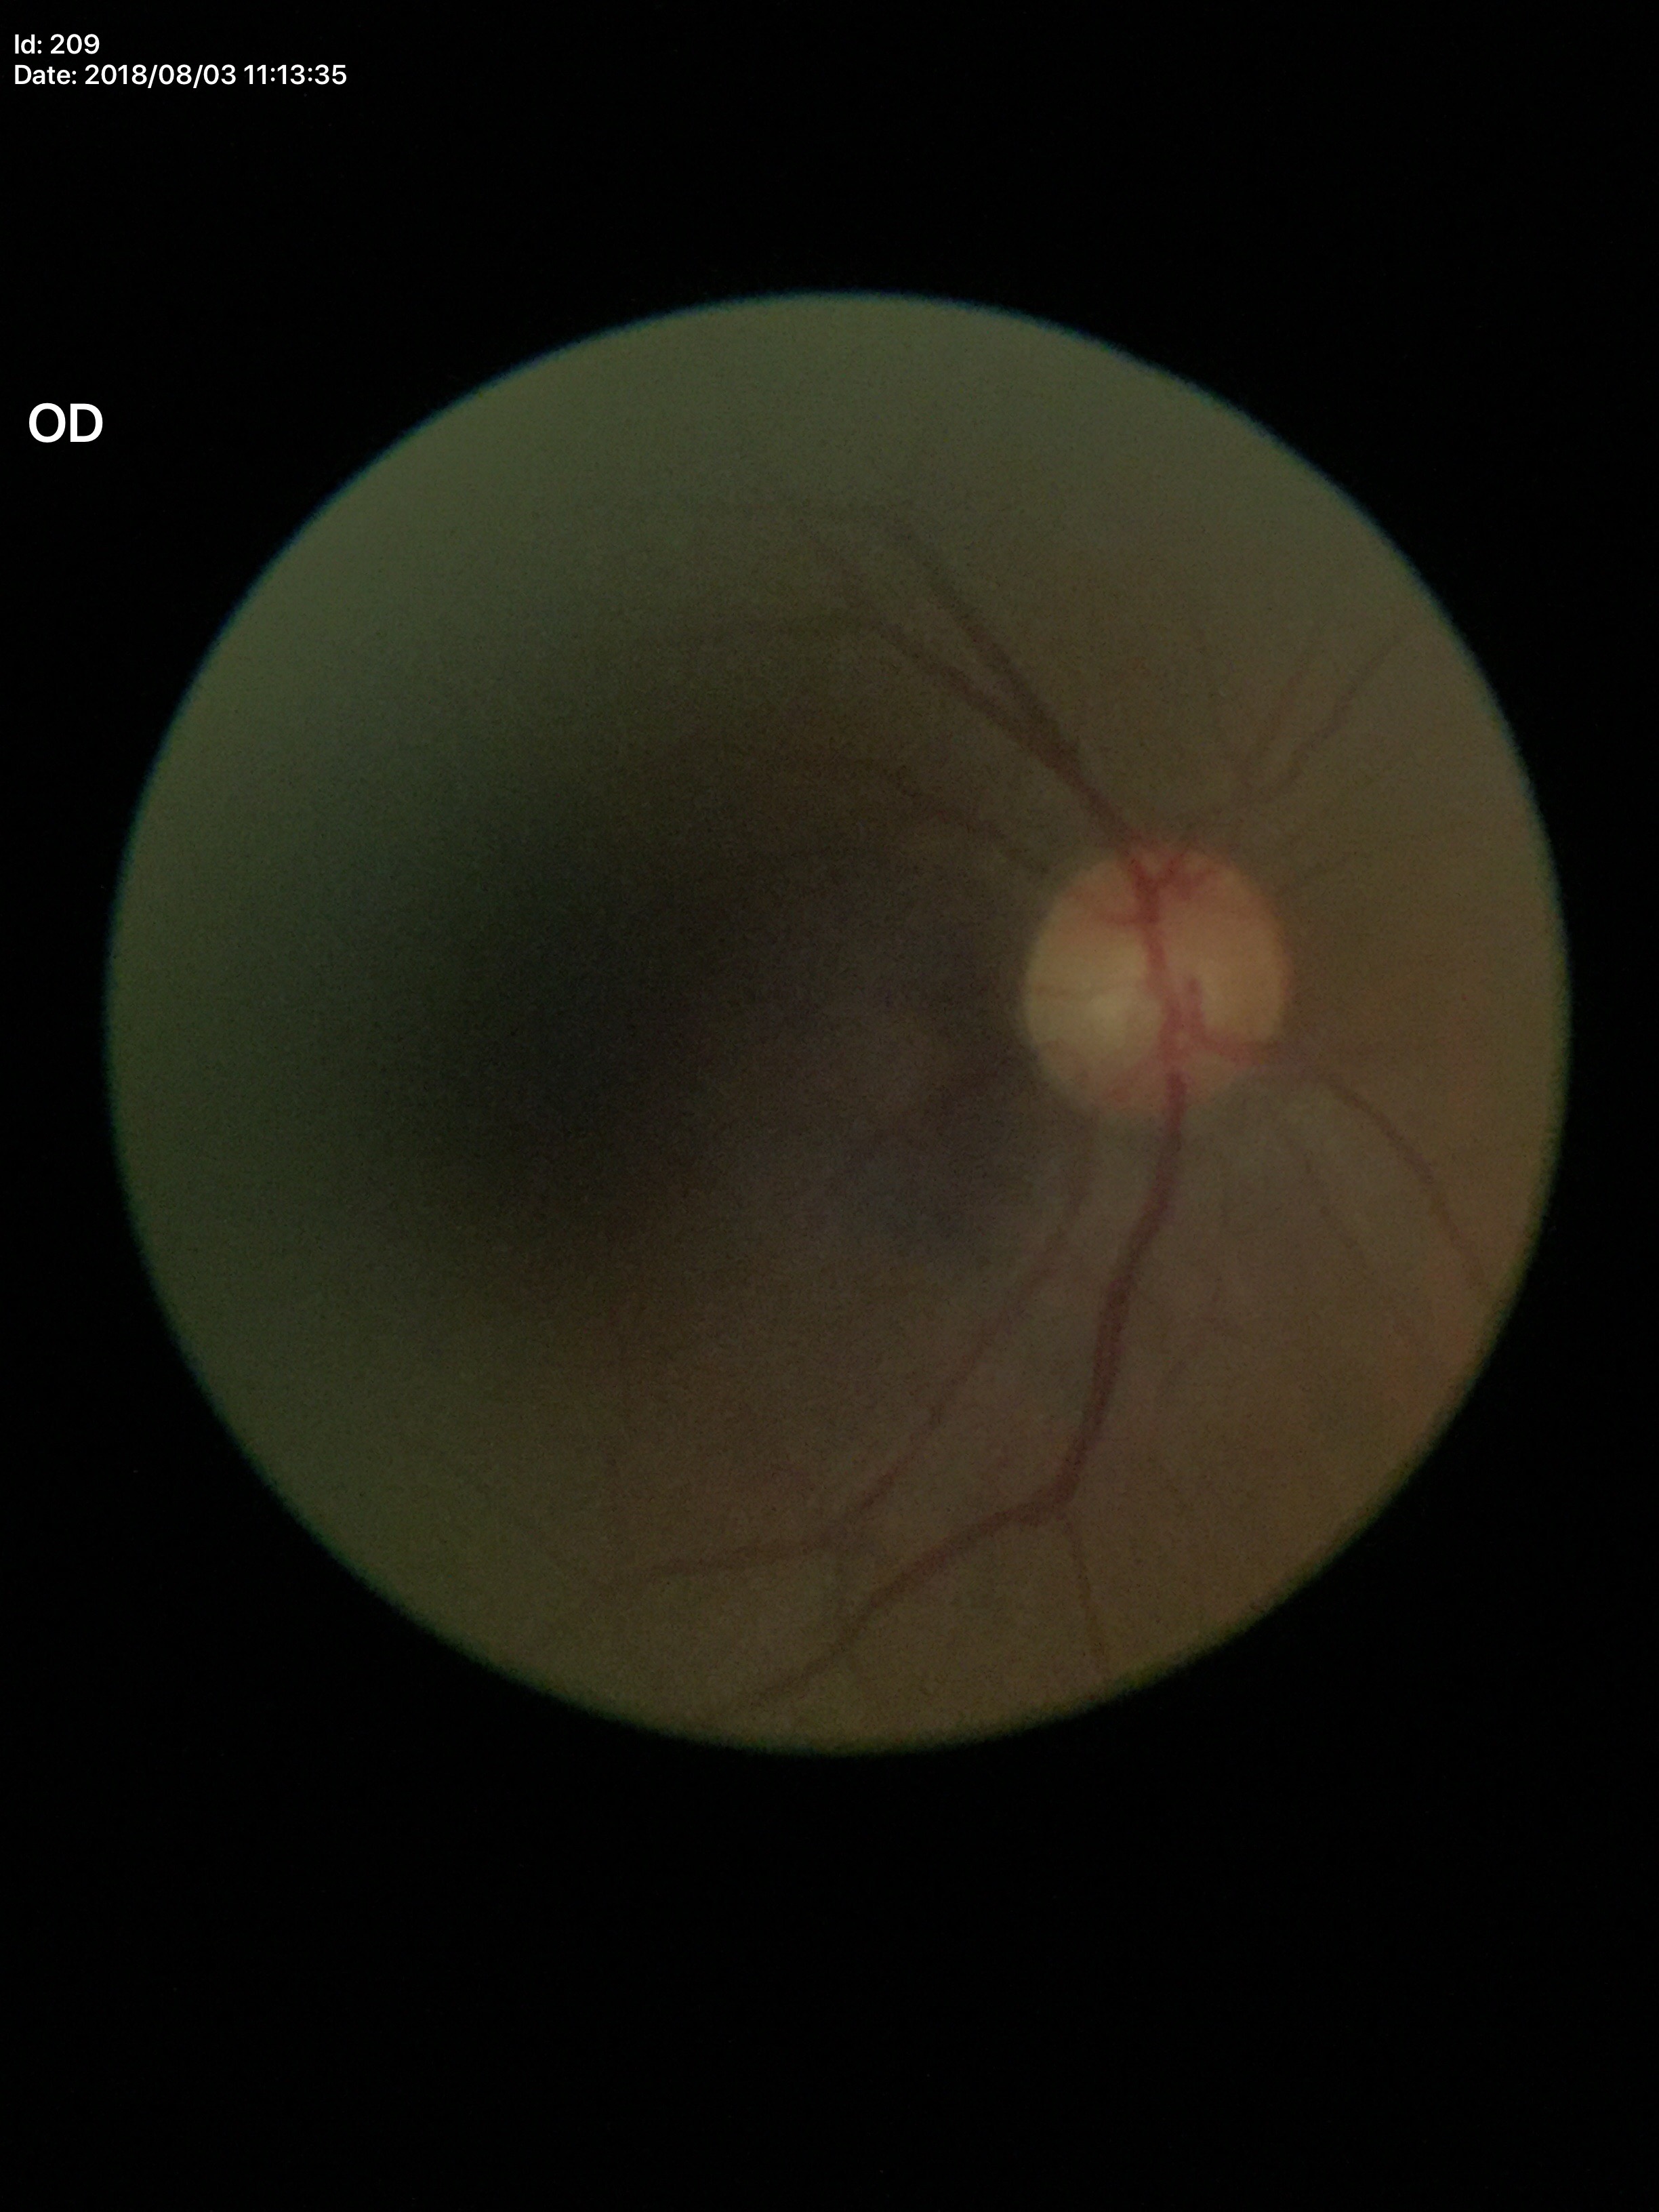
Optic disc analysis:
- Glaucoma evaluation: no suspicious findings
- vertical cup-to-disc ratio: 0.48